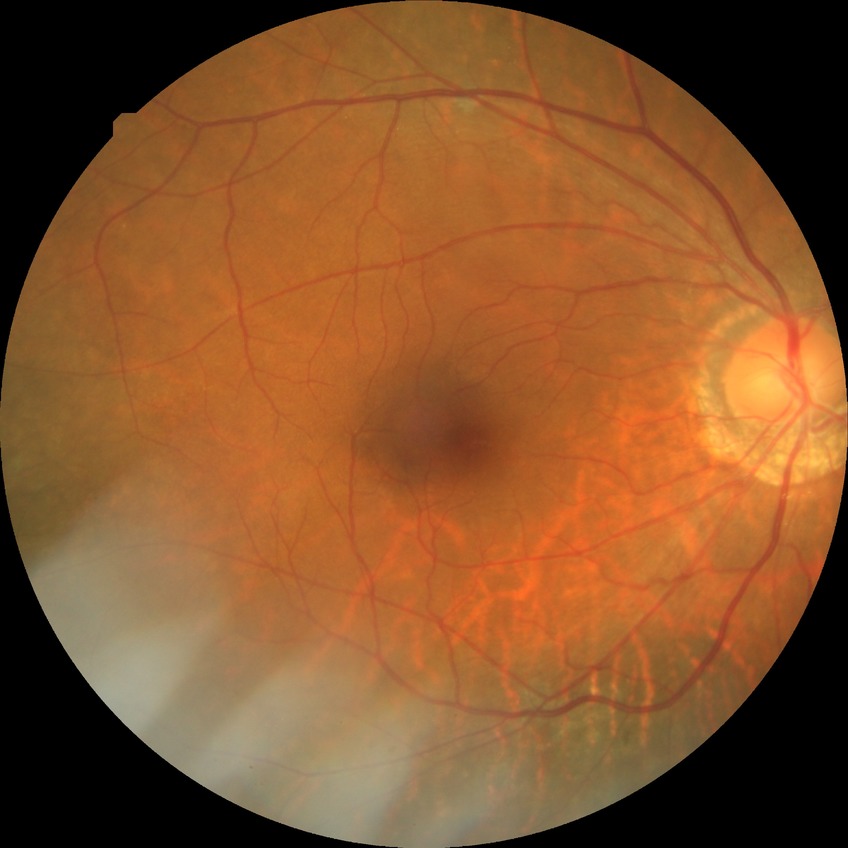 Retinopathy grade is no diabetic retinopathy.